240 by 240 pixels. Fundus photo. Captured on a Nidek AFC-330 fundus camera — 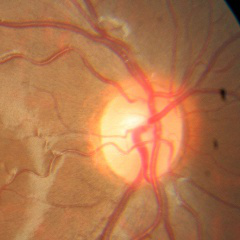 Assessment = no glaucomatous findings.